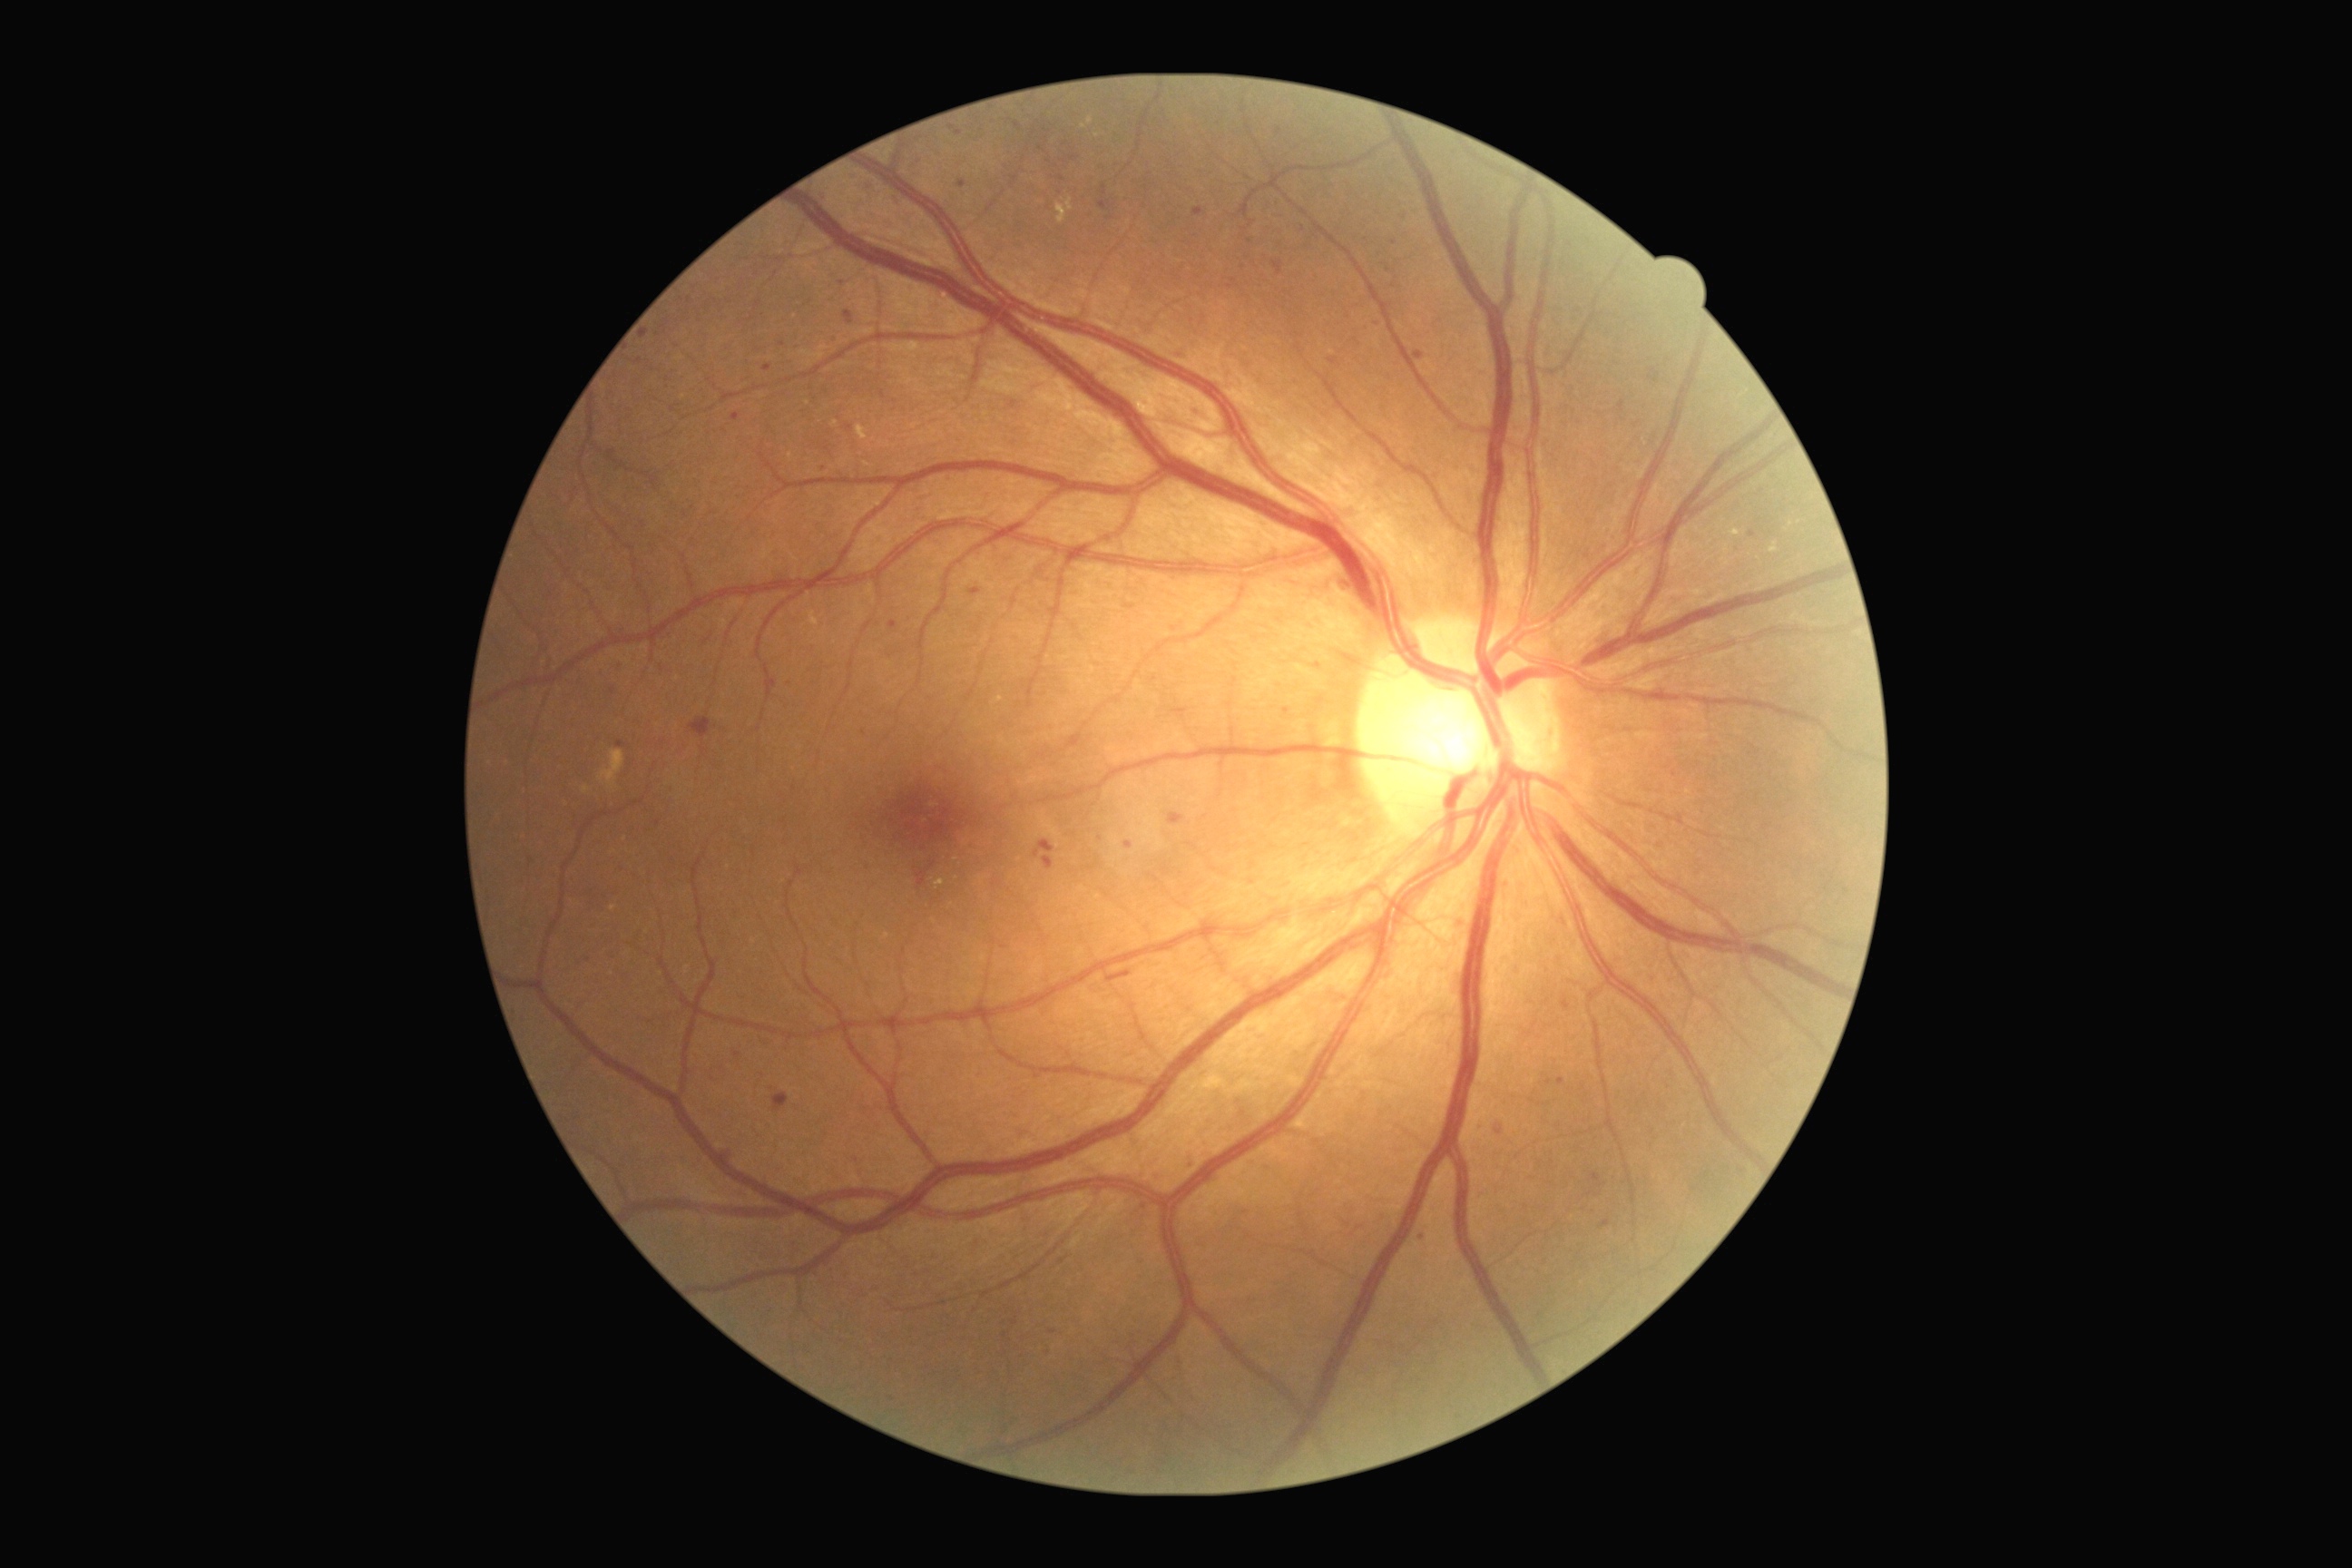
Retinopathy: grade 2 (moderate NPDR)
Lesions identified (partial list):
microaneurysms (partial): x1=779 y1=342 x2=787 y2=348; x1=1340 y1=583 x2=1349 y2=593; x1=607 y1=451 x2=618 y2=464; x1=1562 y1=999 x2=1571 y2=1010; x1=1558 y1=1077 x2=1565 y2=1086; x1=1070 y1=155 x2=1079 y2=161; x1=732 y1=413 x2=740 y2=422; x1=1099 y1=201 x2=1110 y2=210; x1=1014 y1=122 x2=1021 y2=130
Small microaneurysms approximately at 1180, 355; 1652, 371; 1388, 270; 645, 336; 657, 824; 613, 691; 1053, 1331